NIDEK AFC-230 fundus camera — 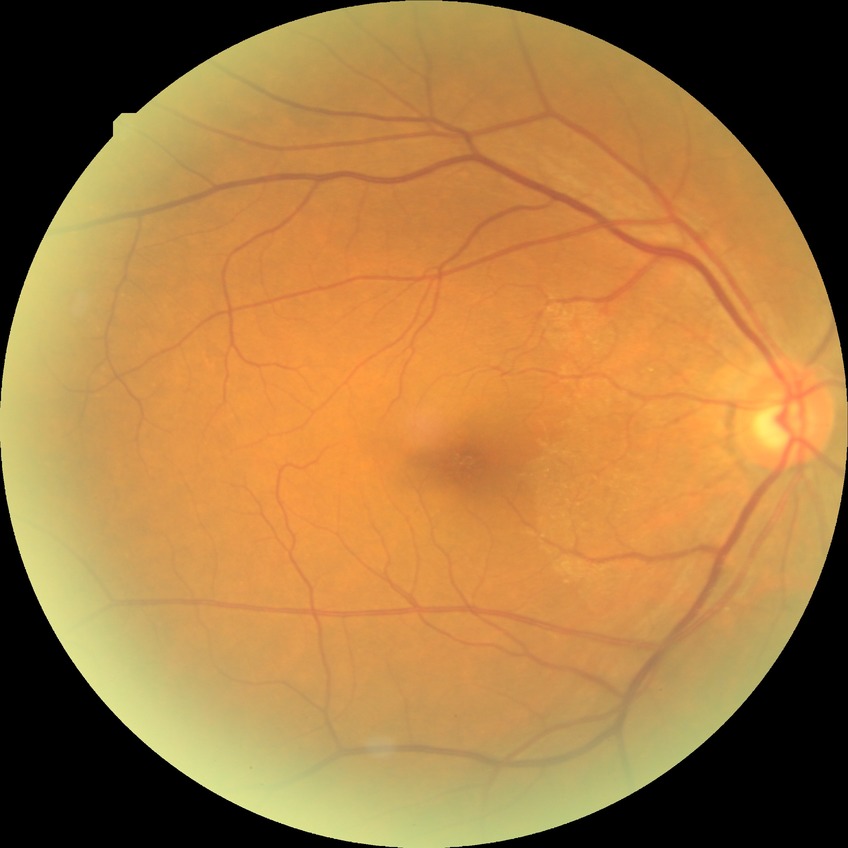
Modified Davis grading: no diabetic retinopathy.